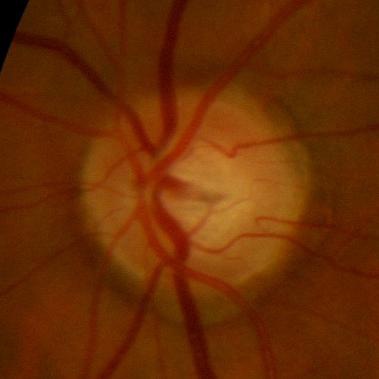

Optic nerve head appearance consistent with no signs of glaucoma.